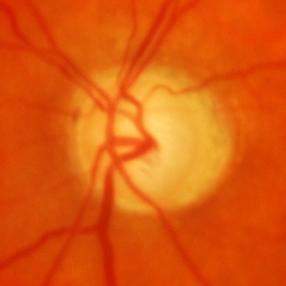

Impression: glaucomatous findings.